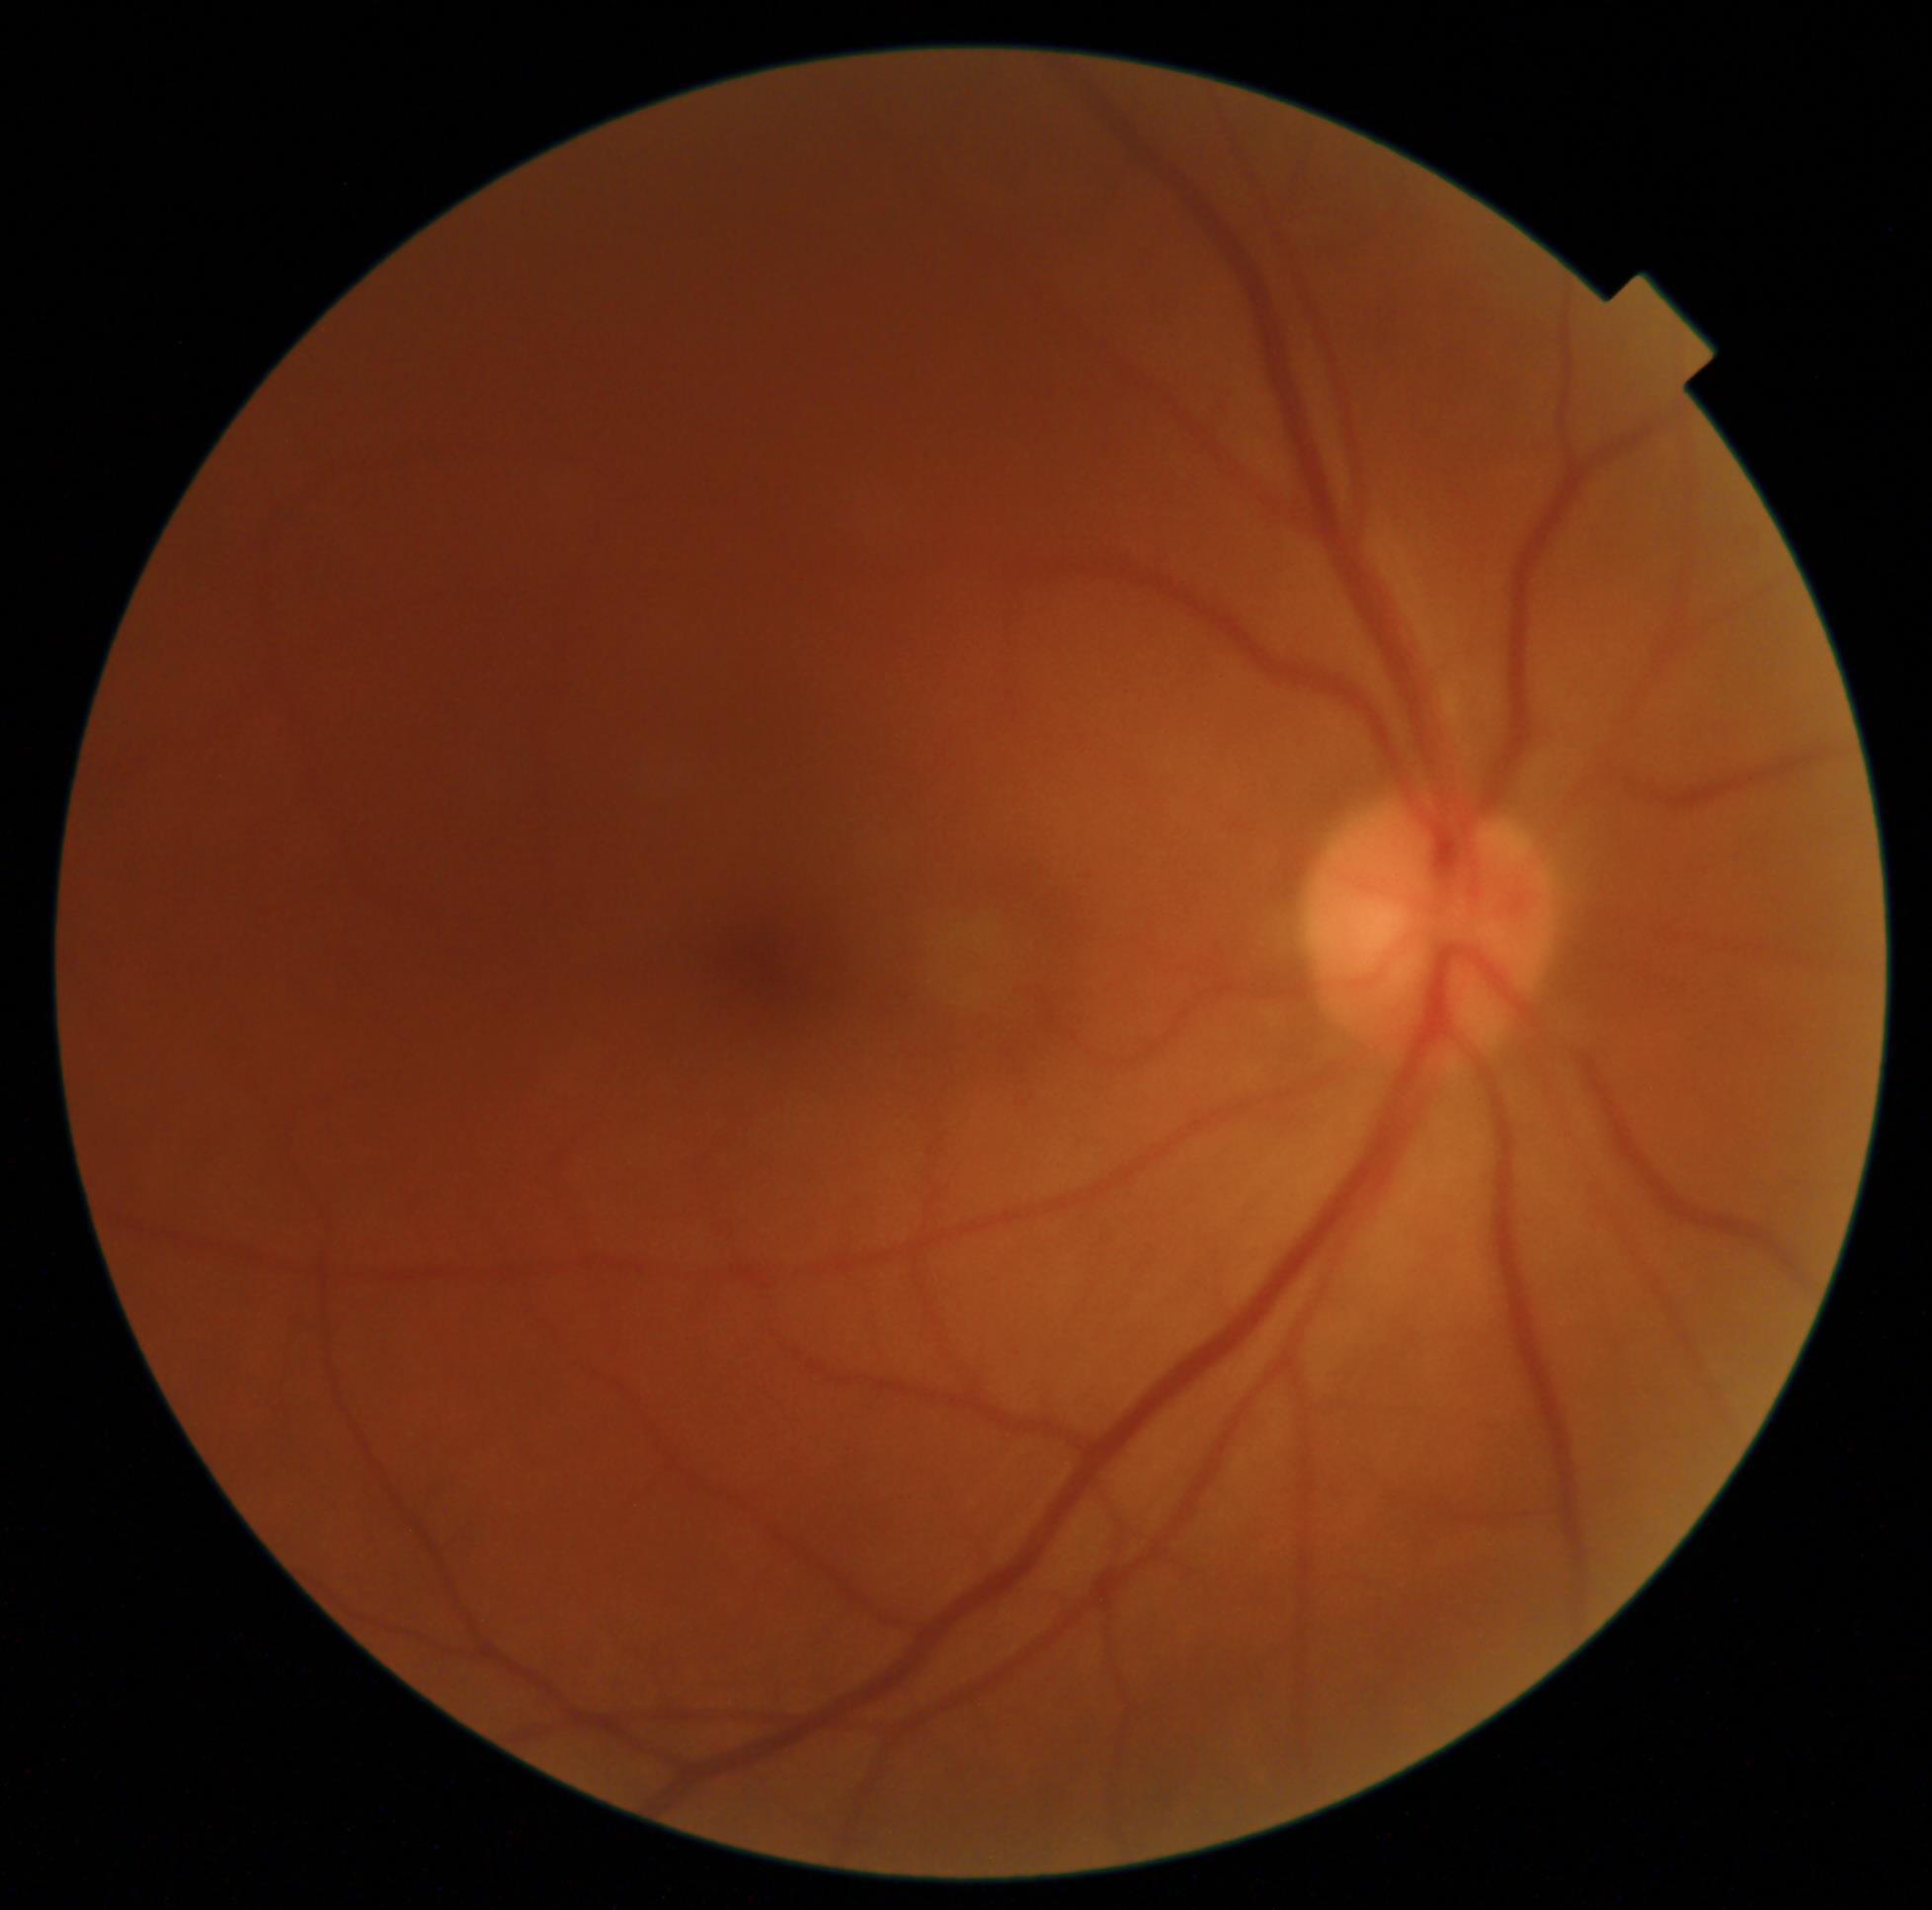 DR grade is no apparent diabetic retinopathy (0).